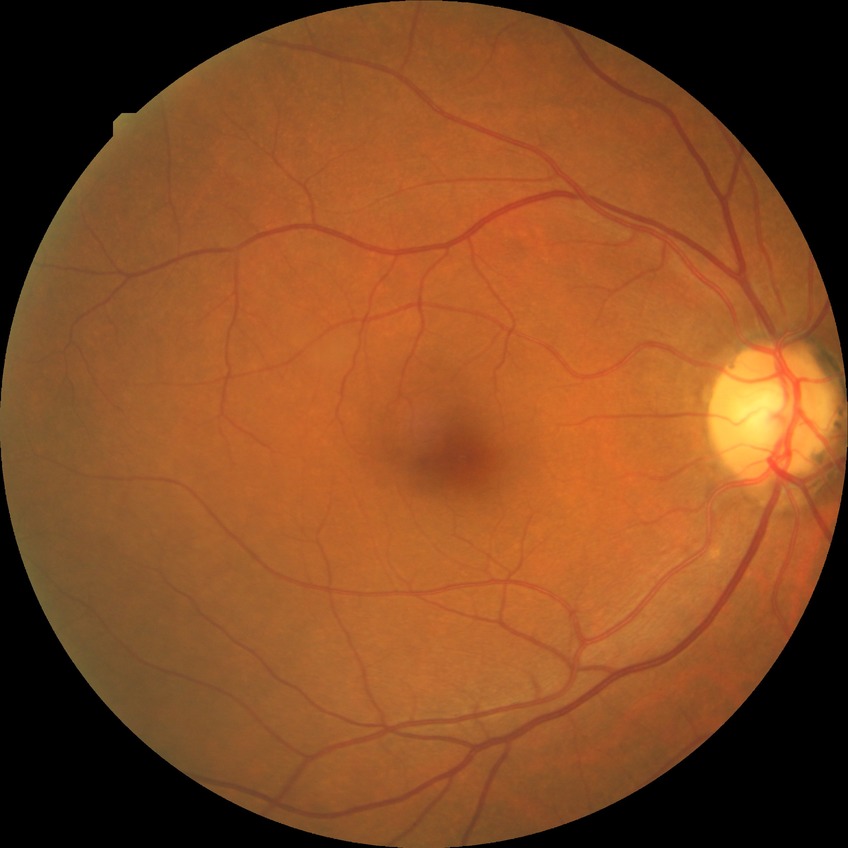
{
  "davis_grade": "NDR"
}